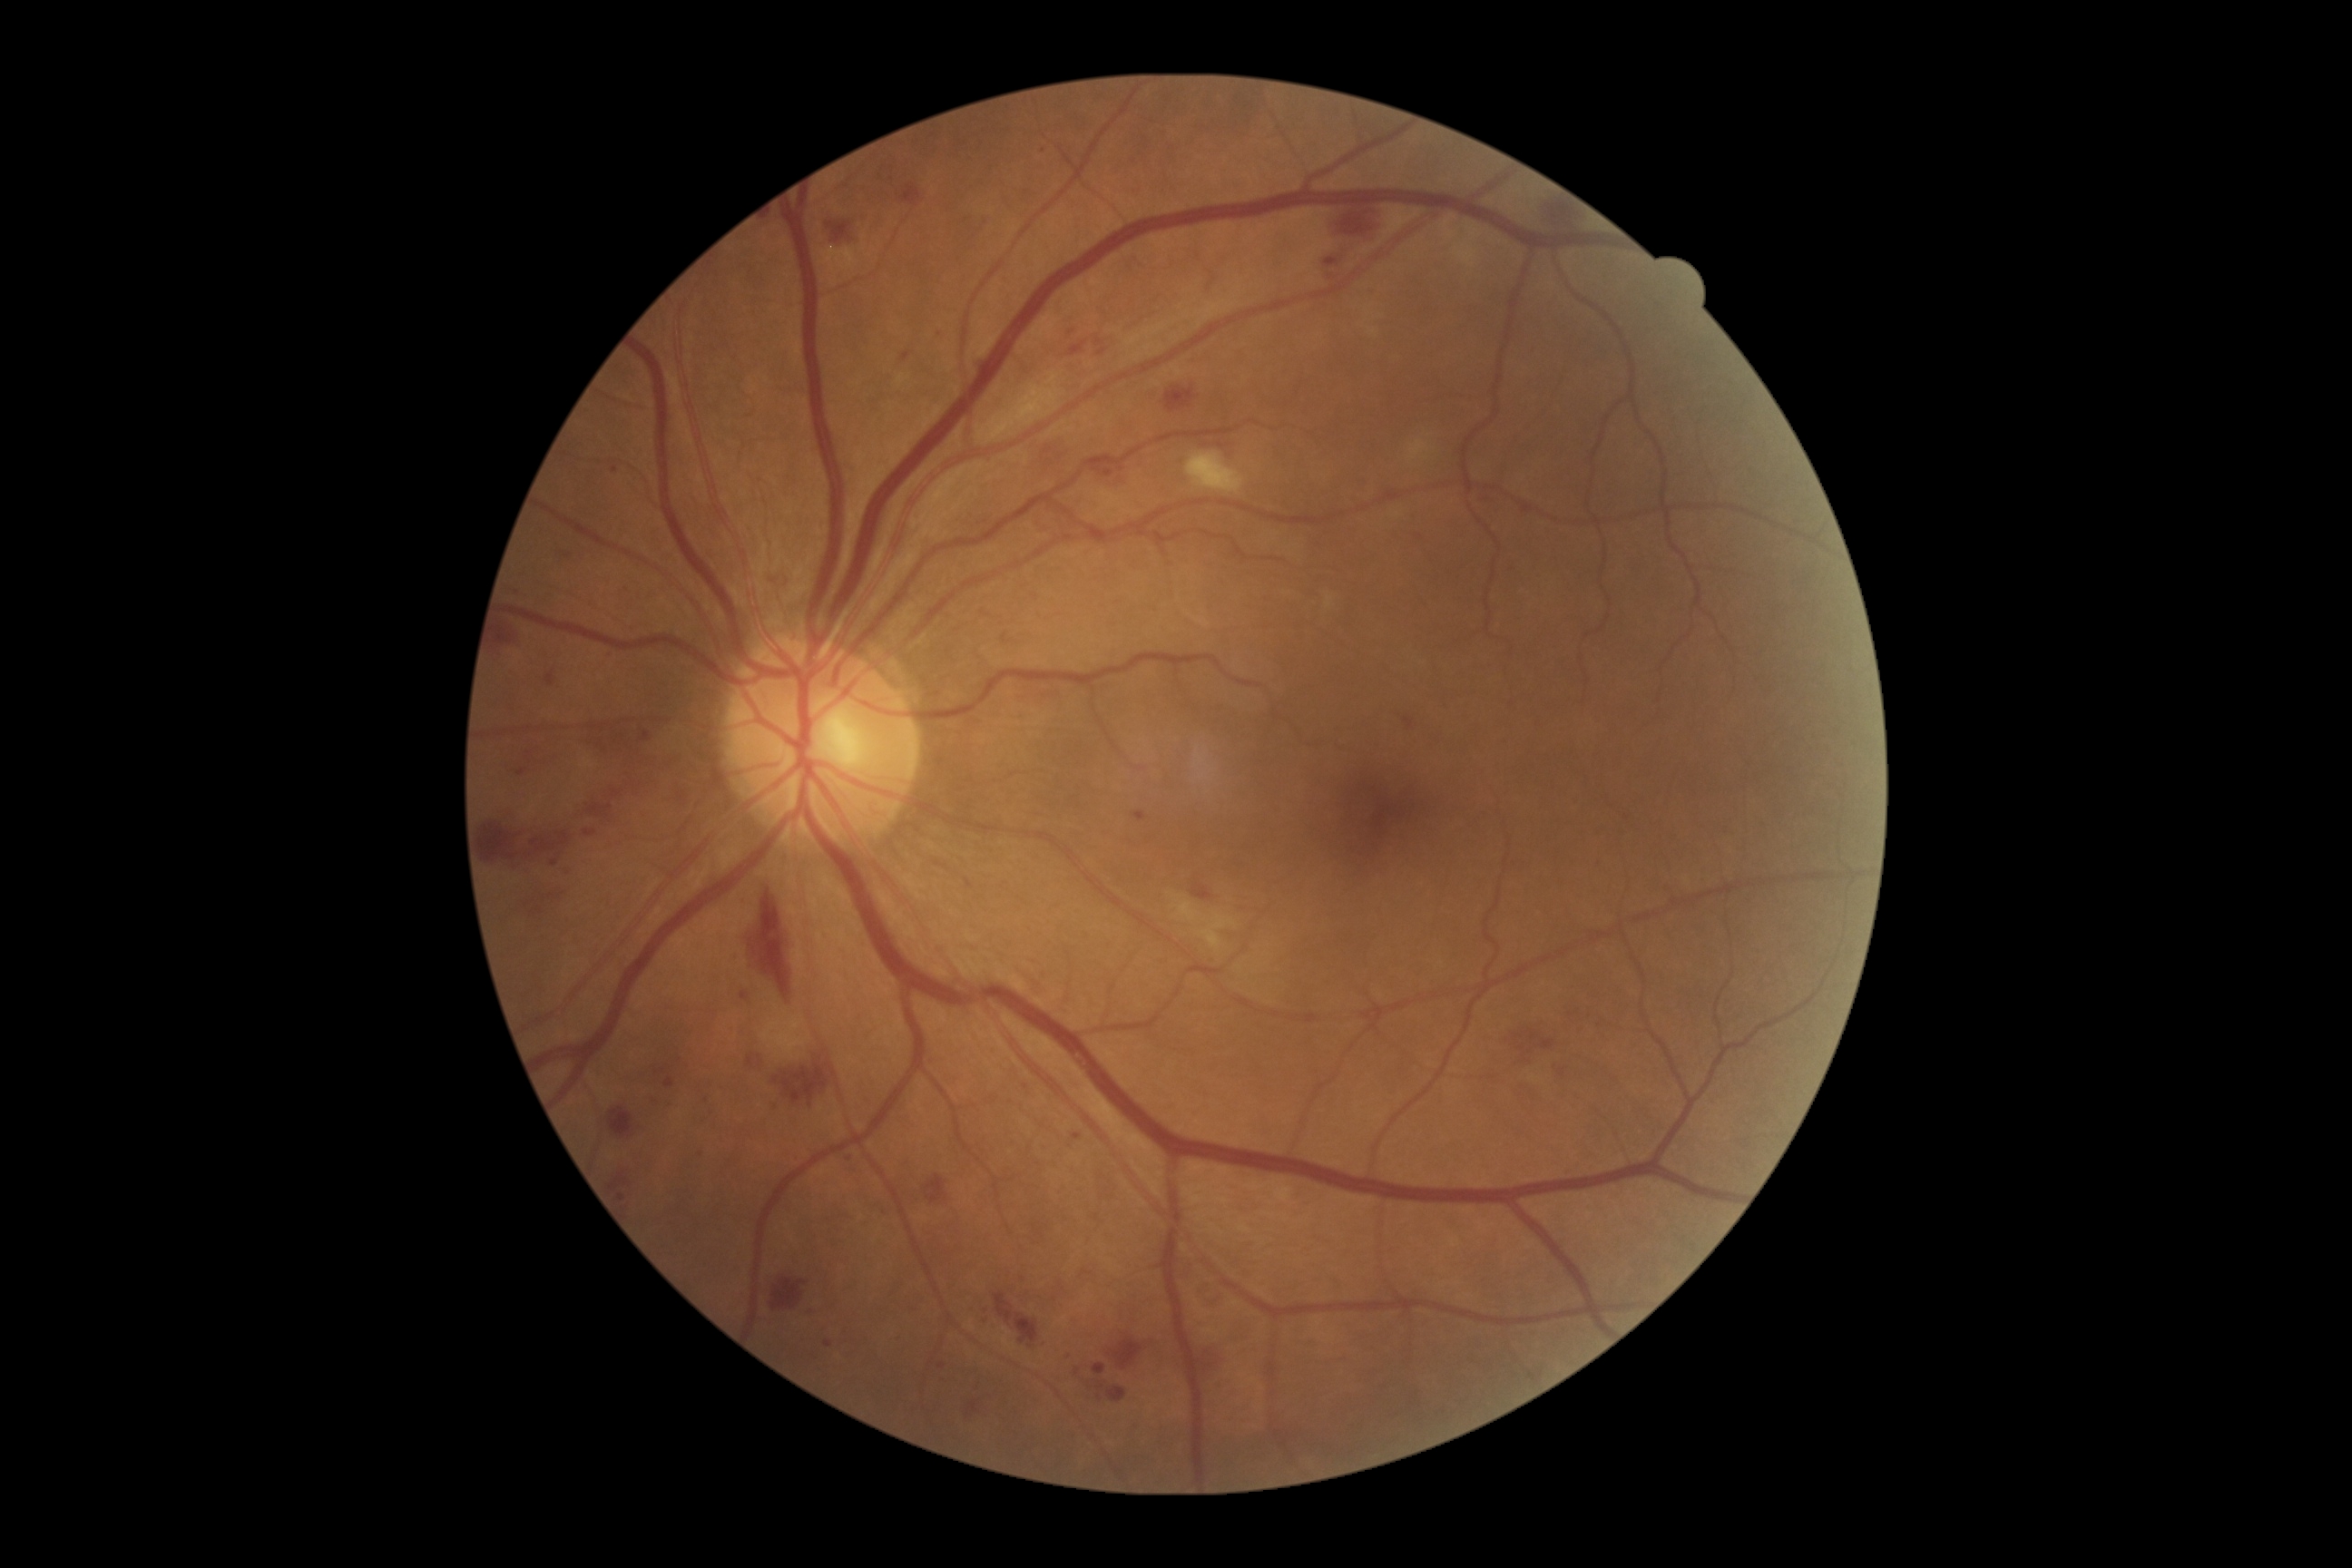 Diabetic retinopathy (DR): moderate non-proliferative diabetic retinopathy (grade 2).